Color fundus image:
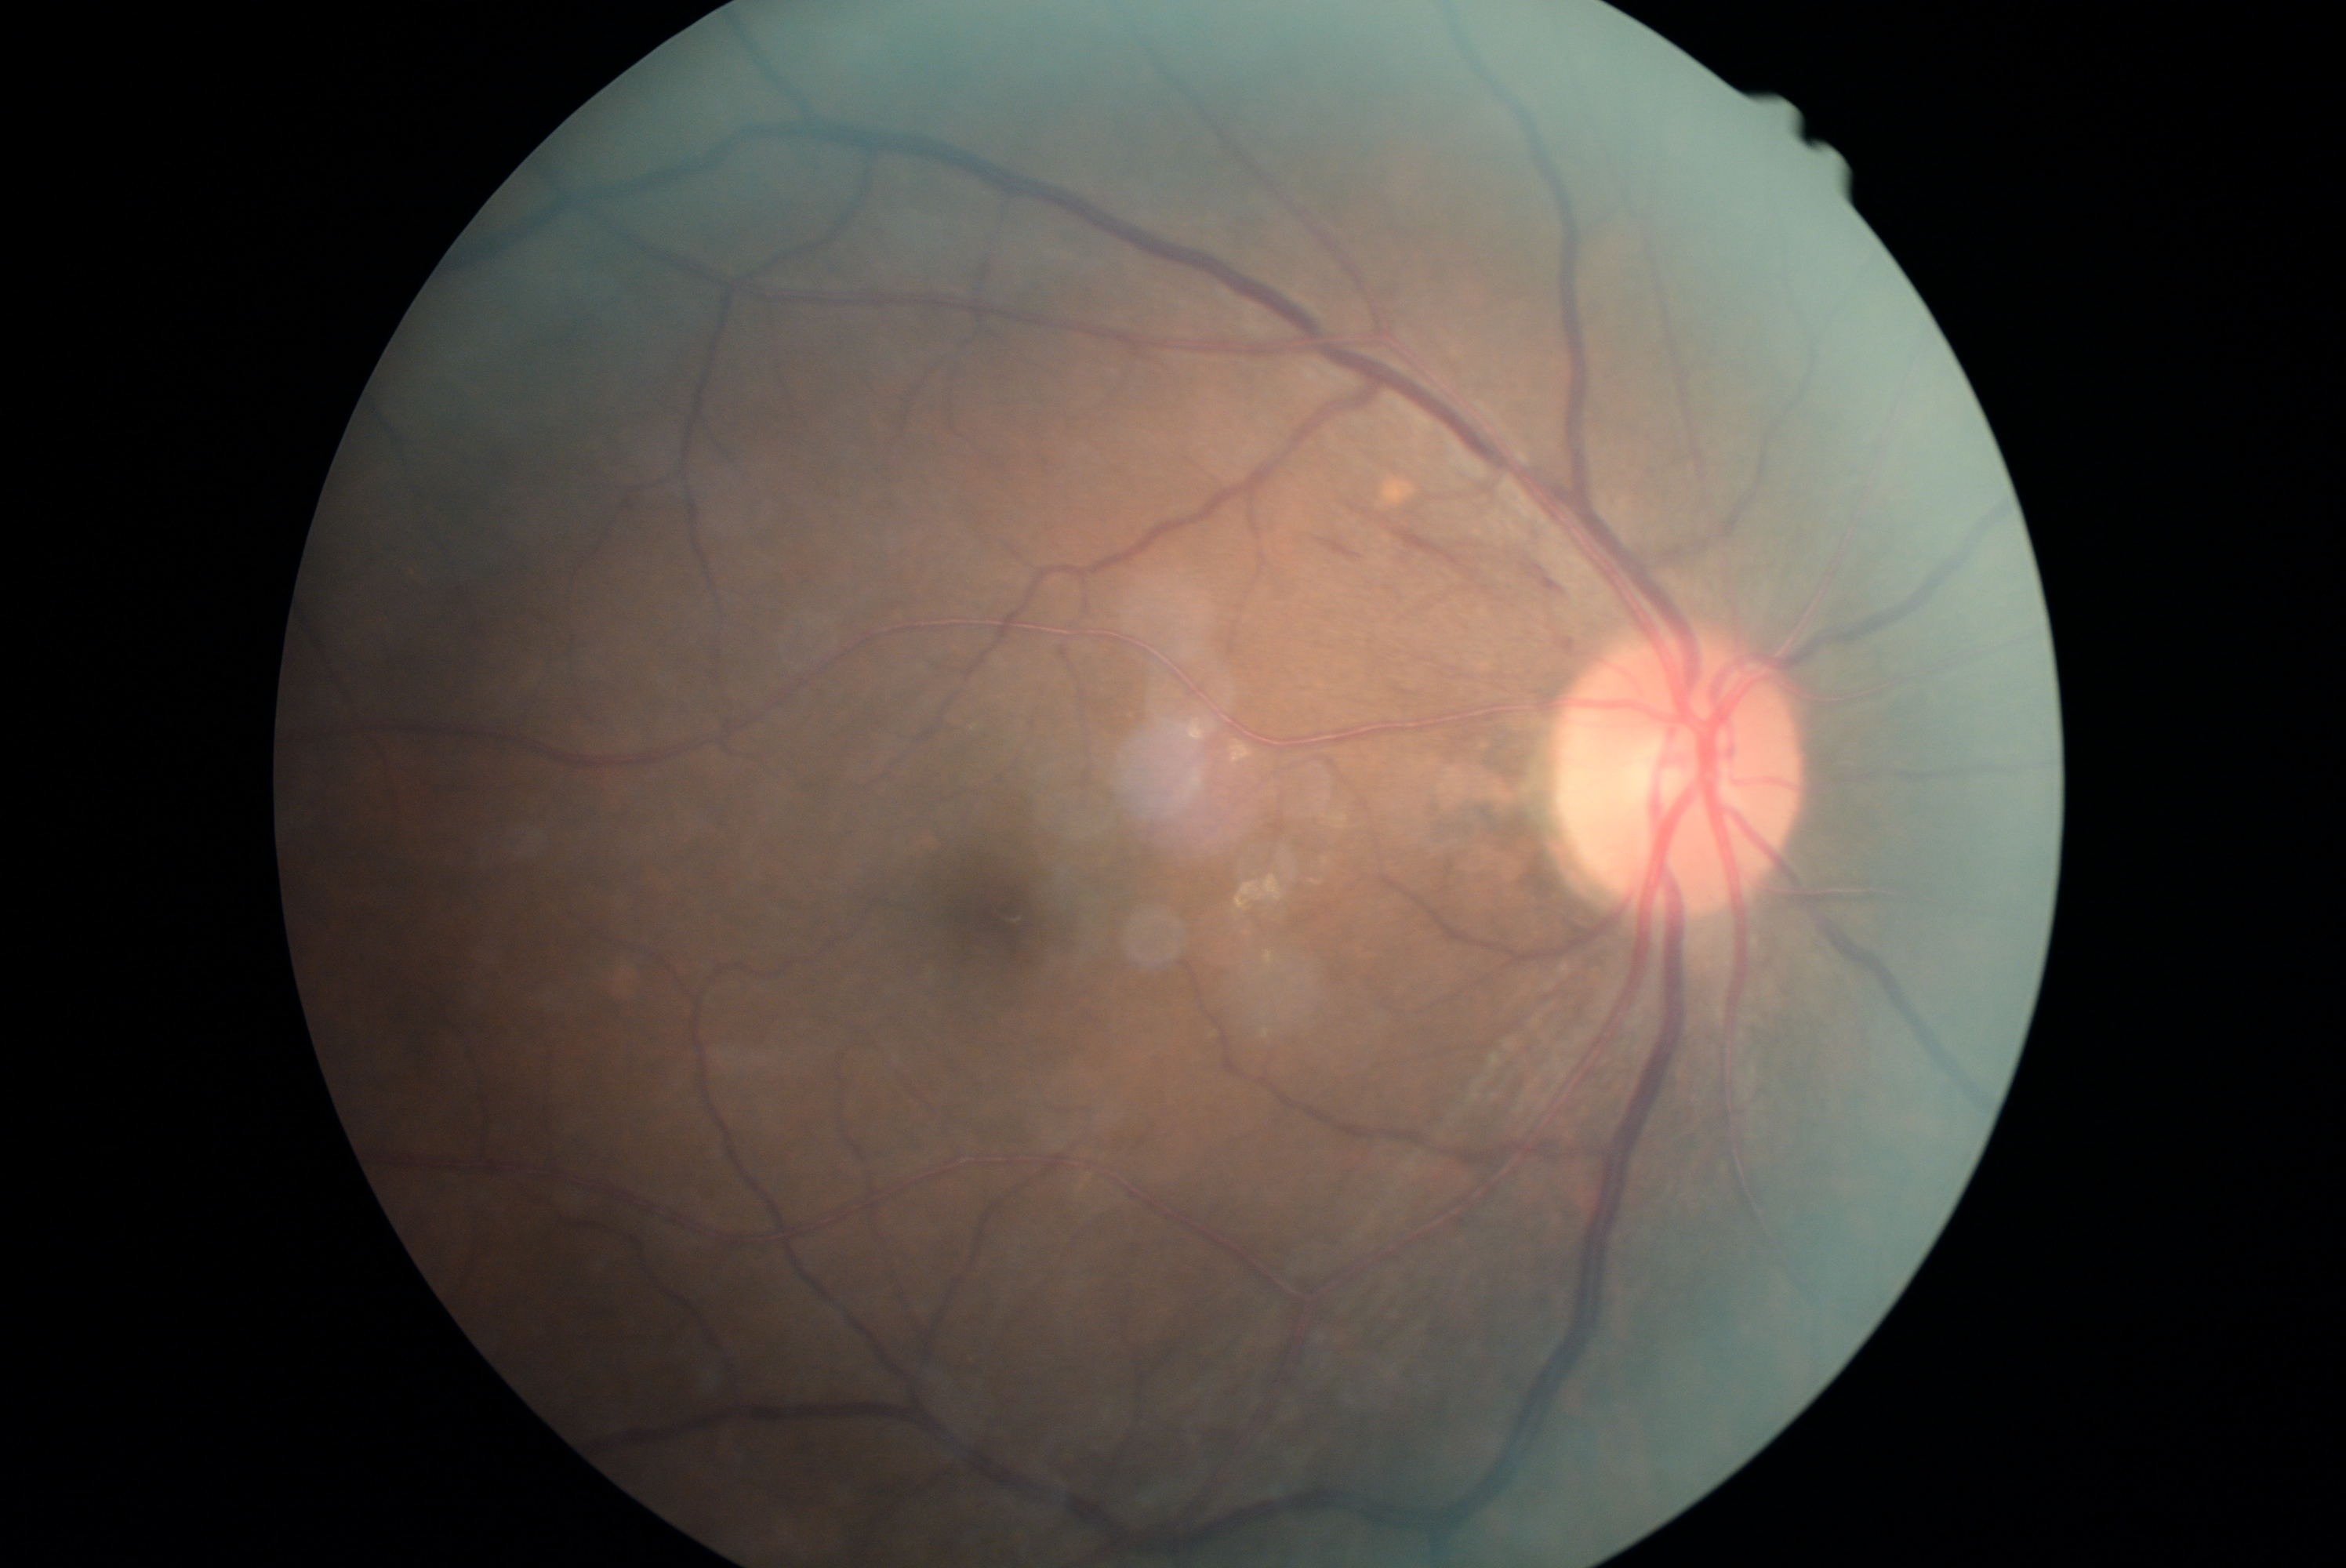

Diabetic retinopathy grade: moderate NPDR (2).